424x424 · optic disc-centered crop from a color fundus photograph: 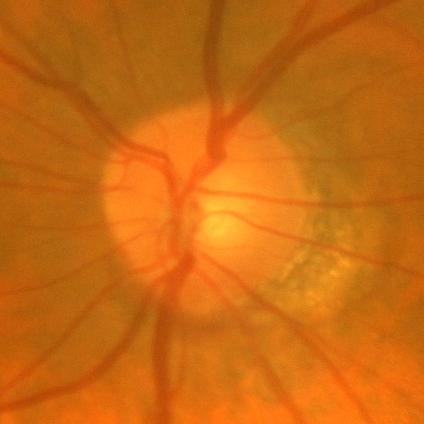

Glaucoma status = no glaucomatous changes.